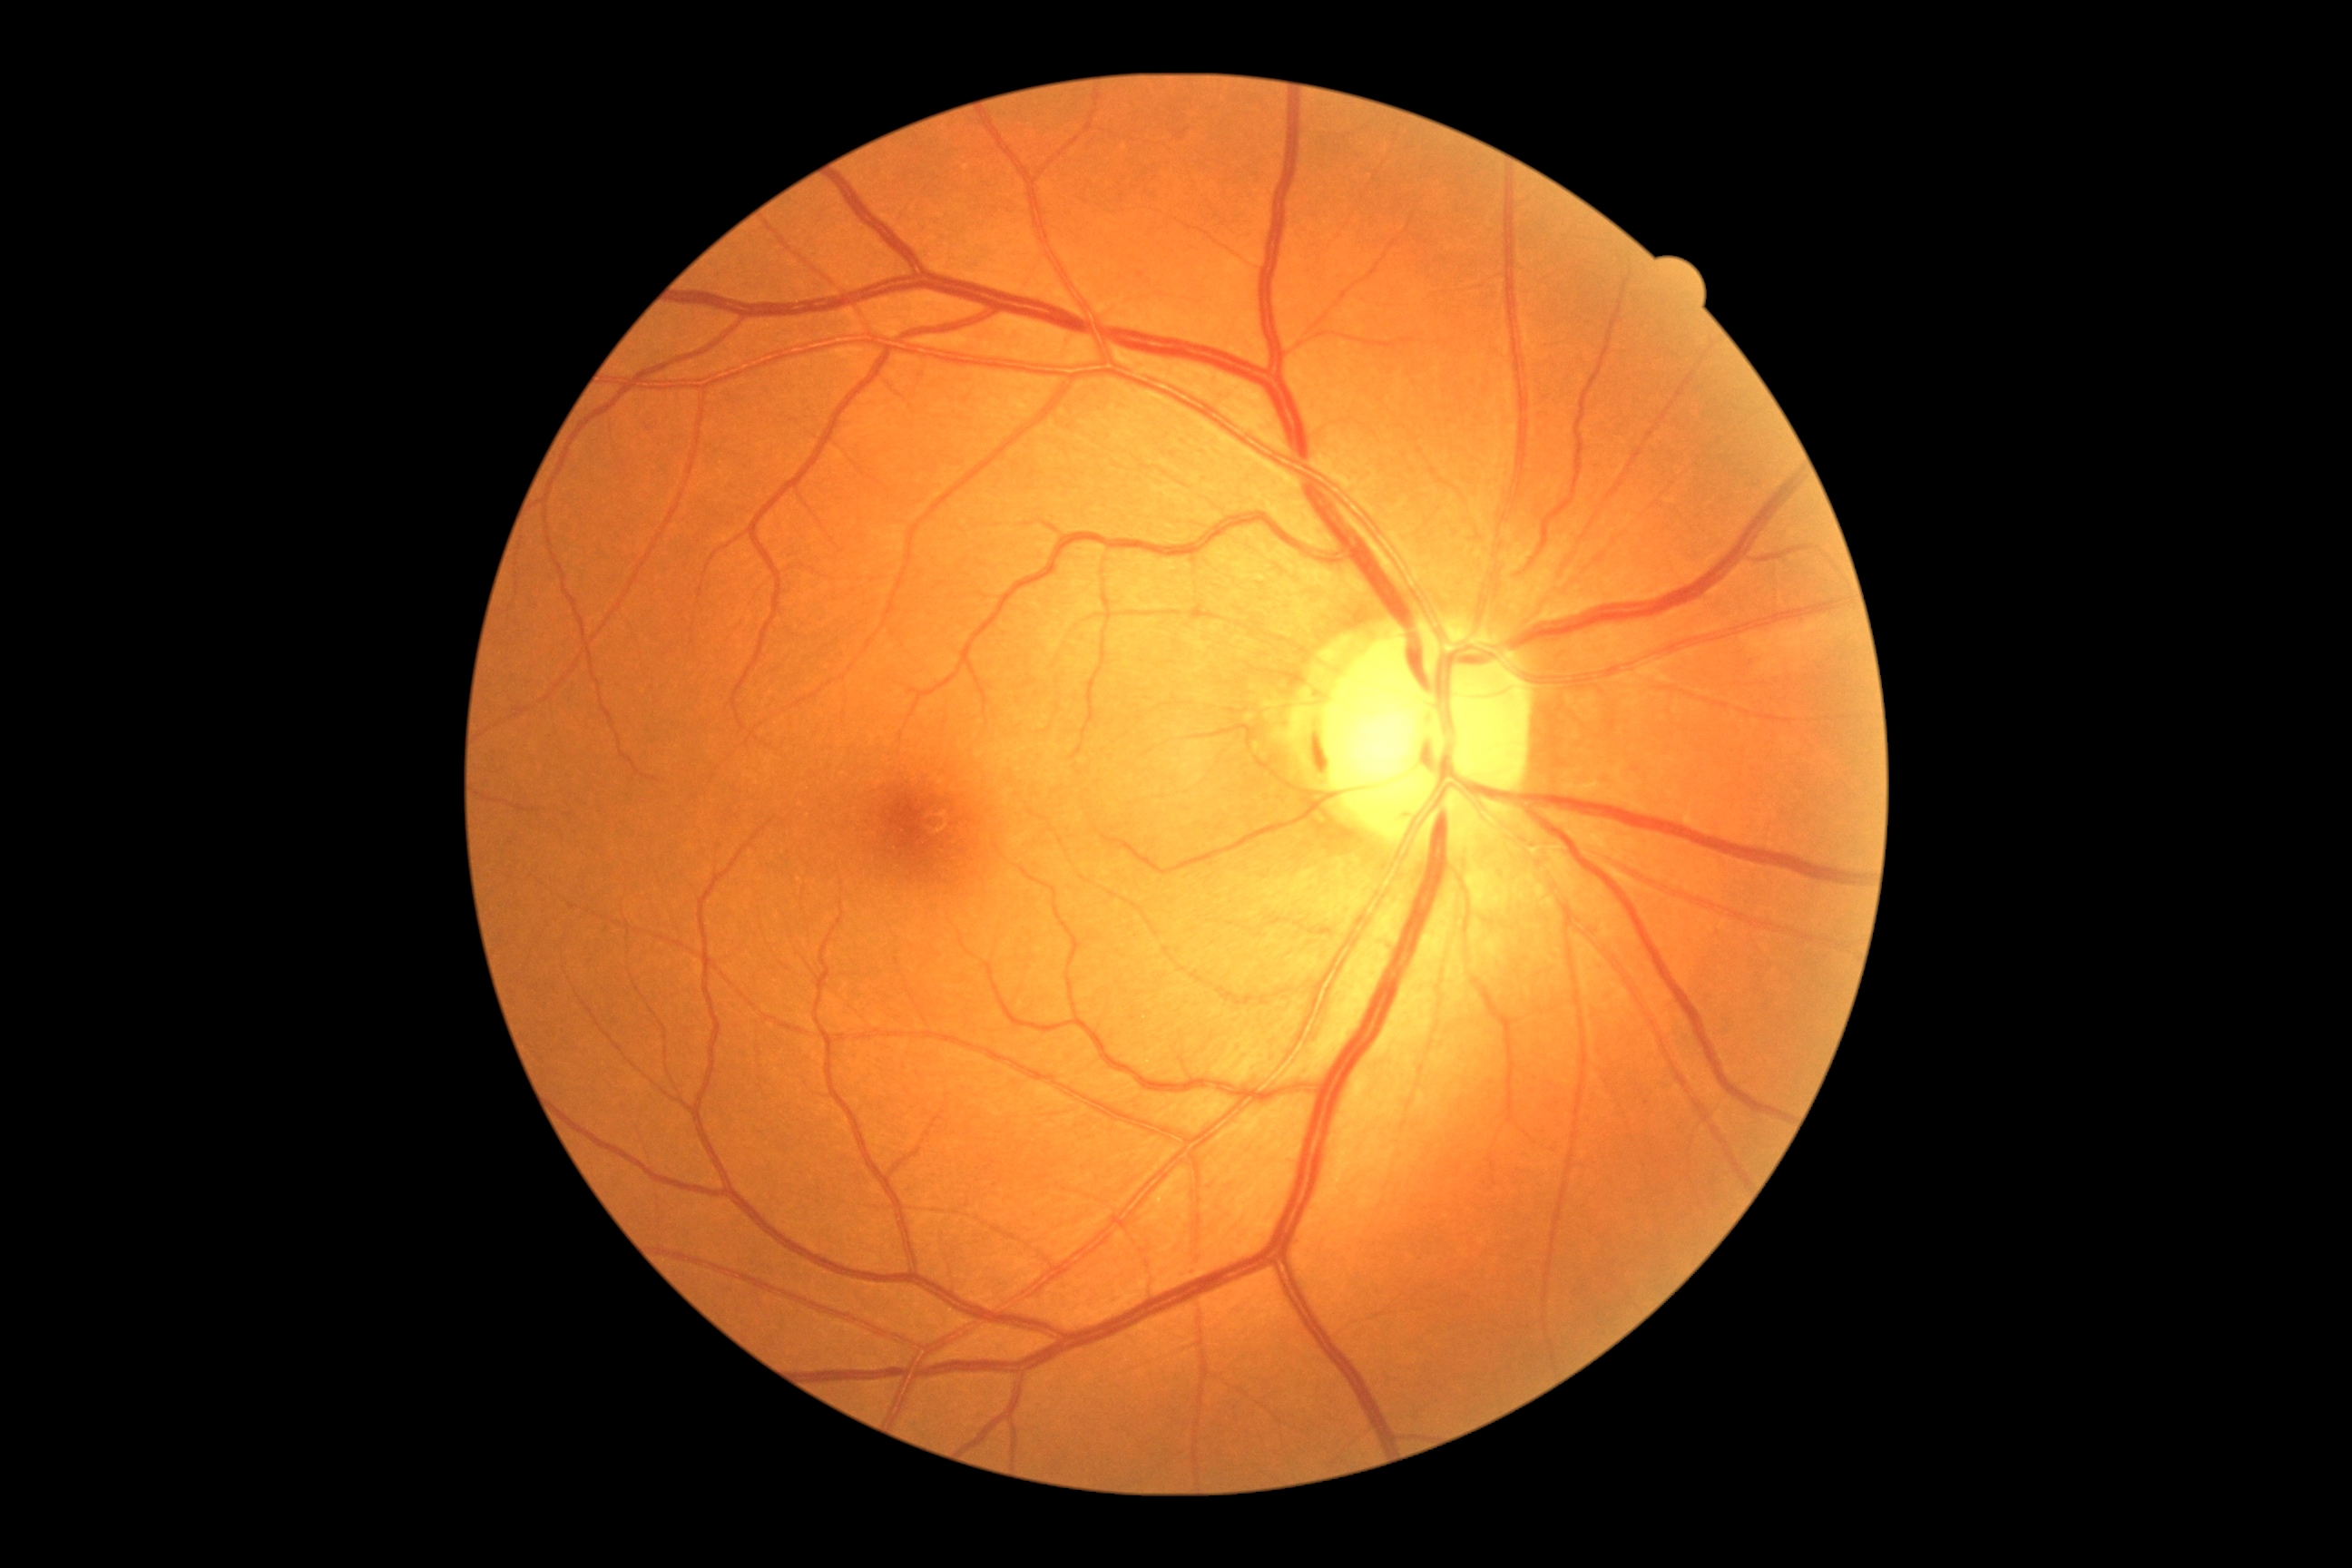
– DR impression — no DR findings
– diabetic retinopathy grade — no apparent diabetic retinopathy (0)